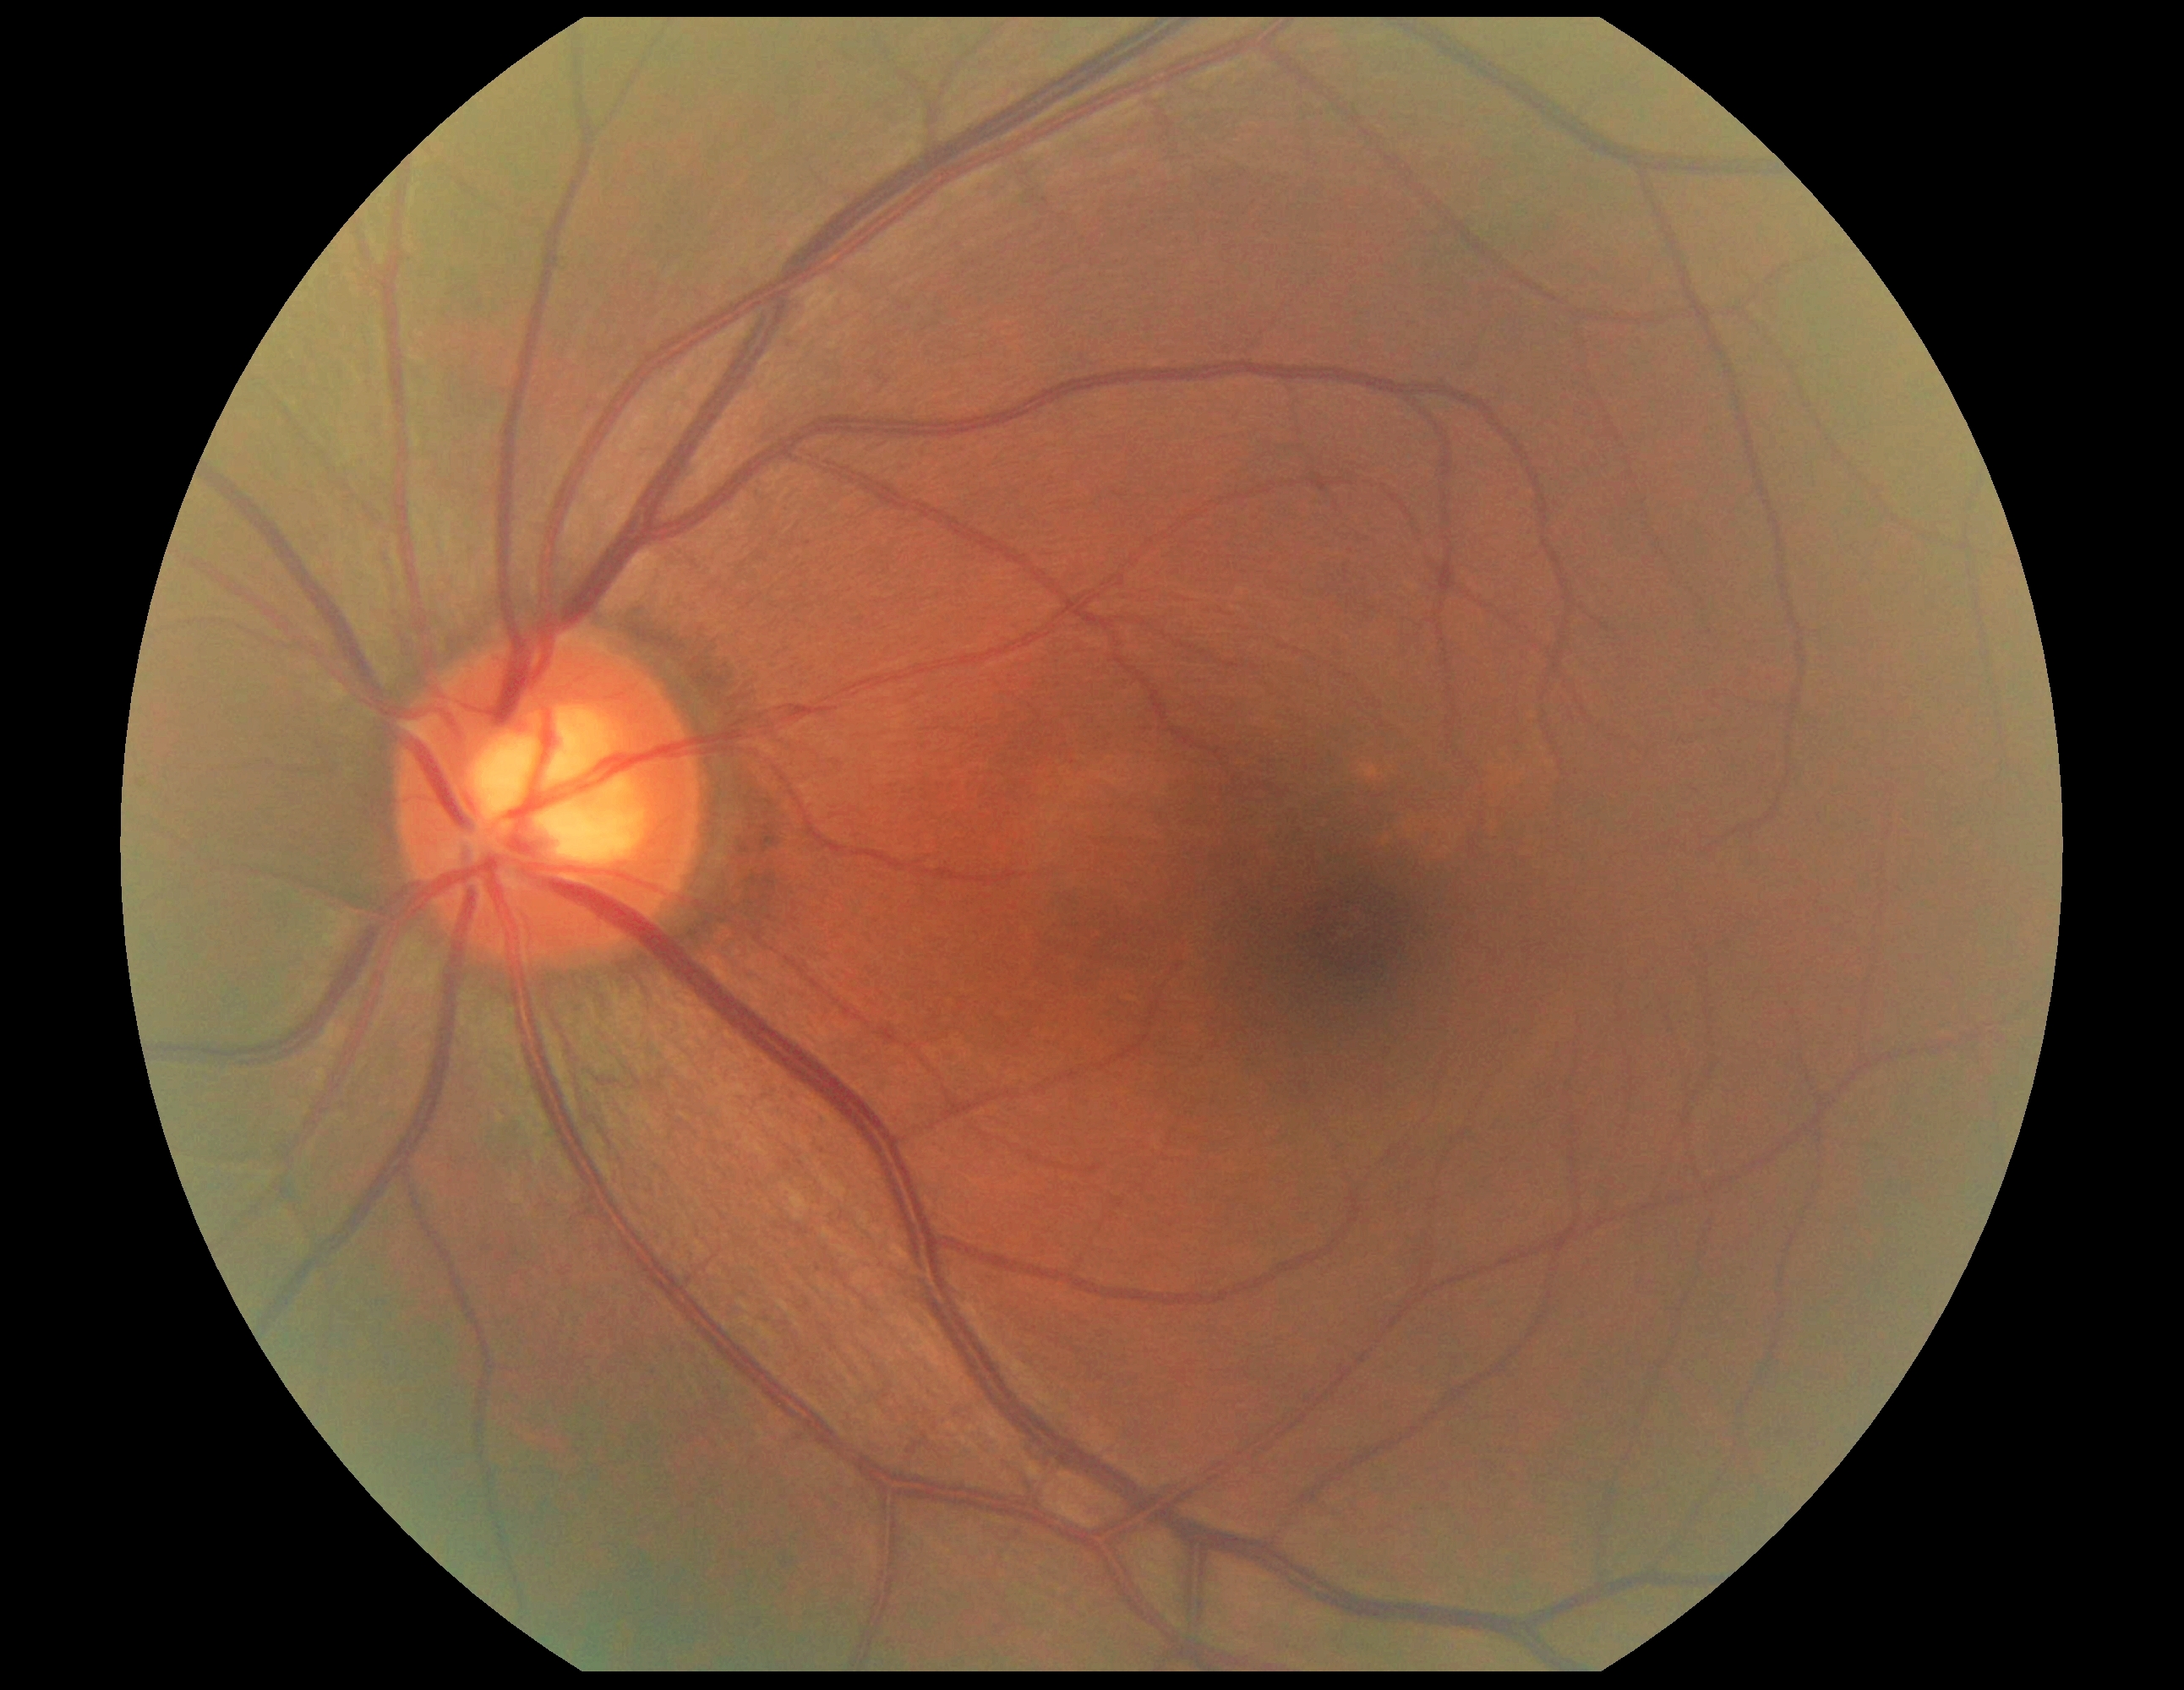 Diabetic retinopathy (DR) is grade 0 (no apparent retinopathy) — no visible signs of diabetic retinopathy.